Non-mydriatic:
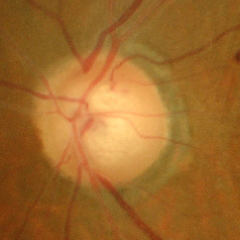
Showing advanced glaucomatous optic neuropathy.